1240x1240 · wide-field fundus photograph from neonatal ROP screening · camera: Phoenix ICON (100° FOV):
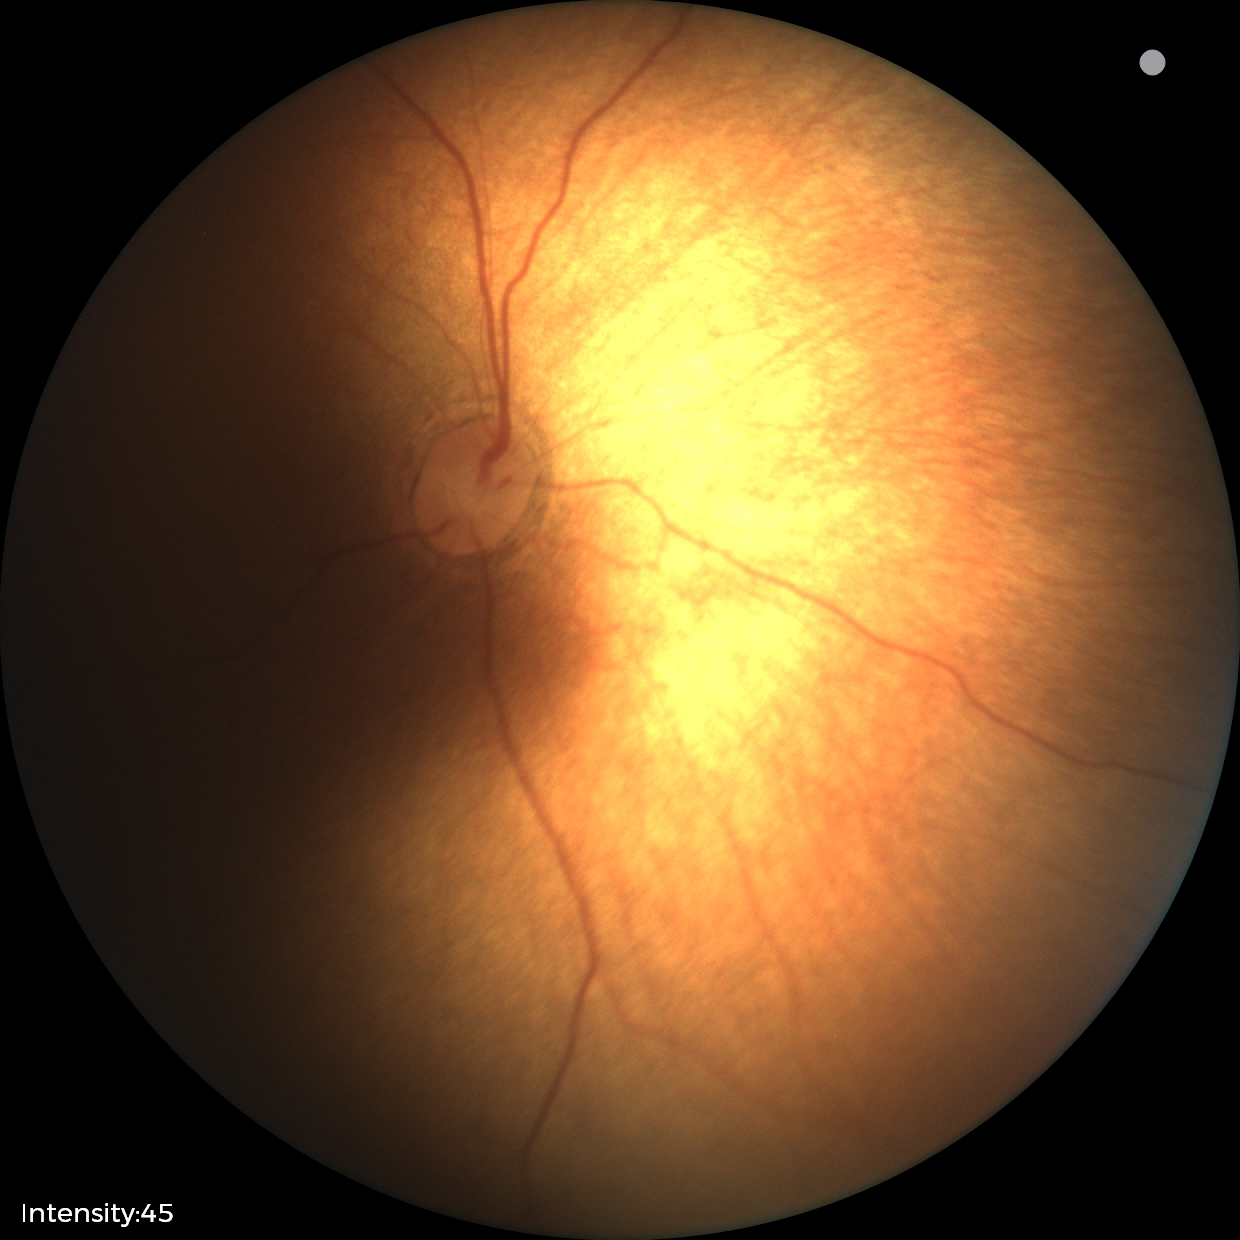 Impression: physiological appearance.